Retinal fundus photograph; 848 x 848 pixels; NIDEK AFC-230
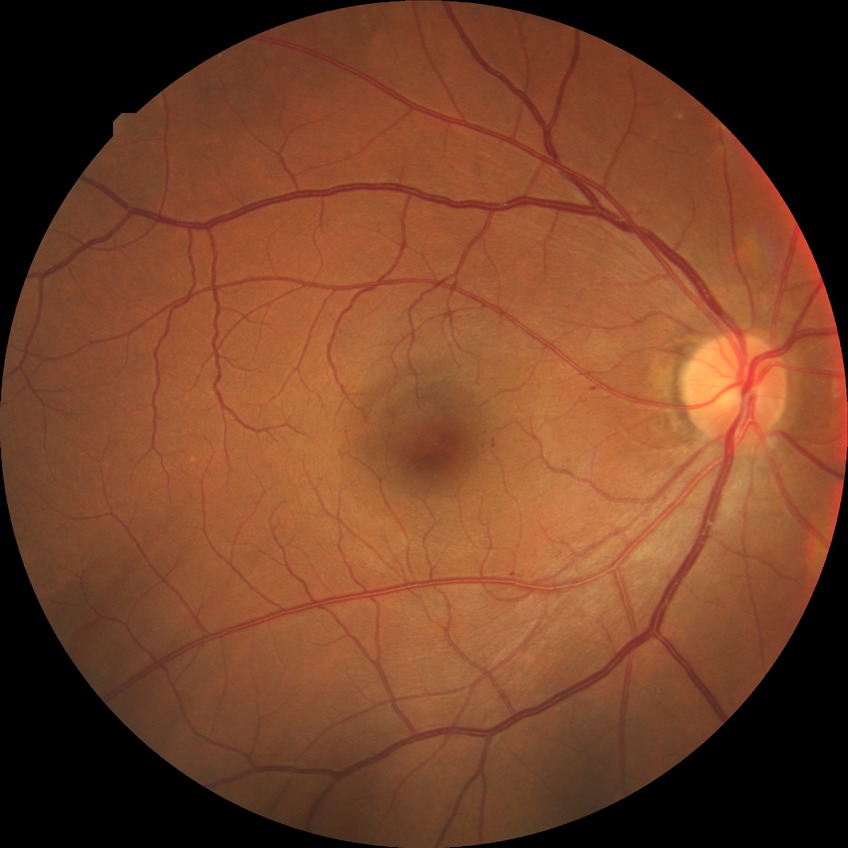
diabetic retinopathy (DR) = SDR (simple diabetic retinopathy)